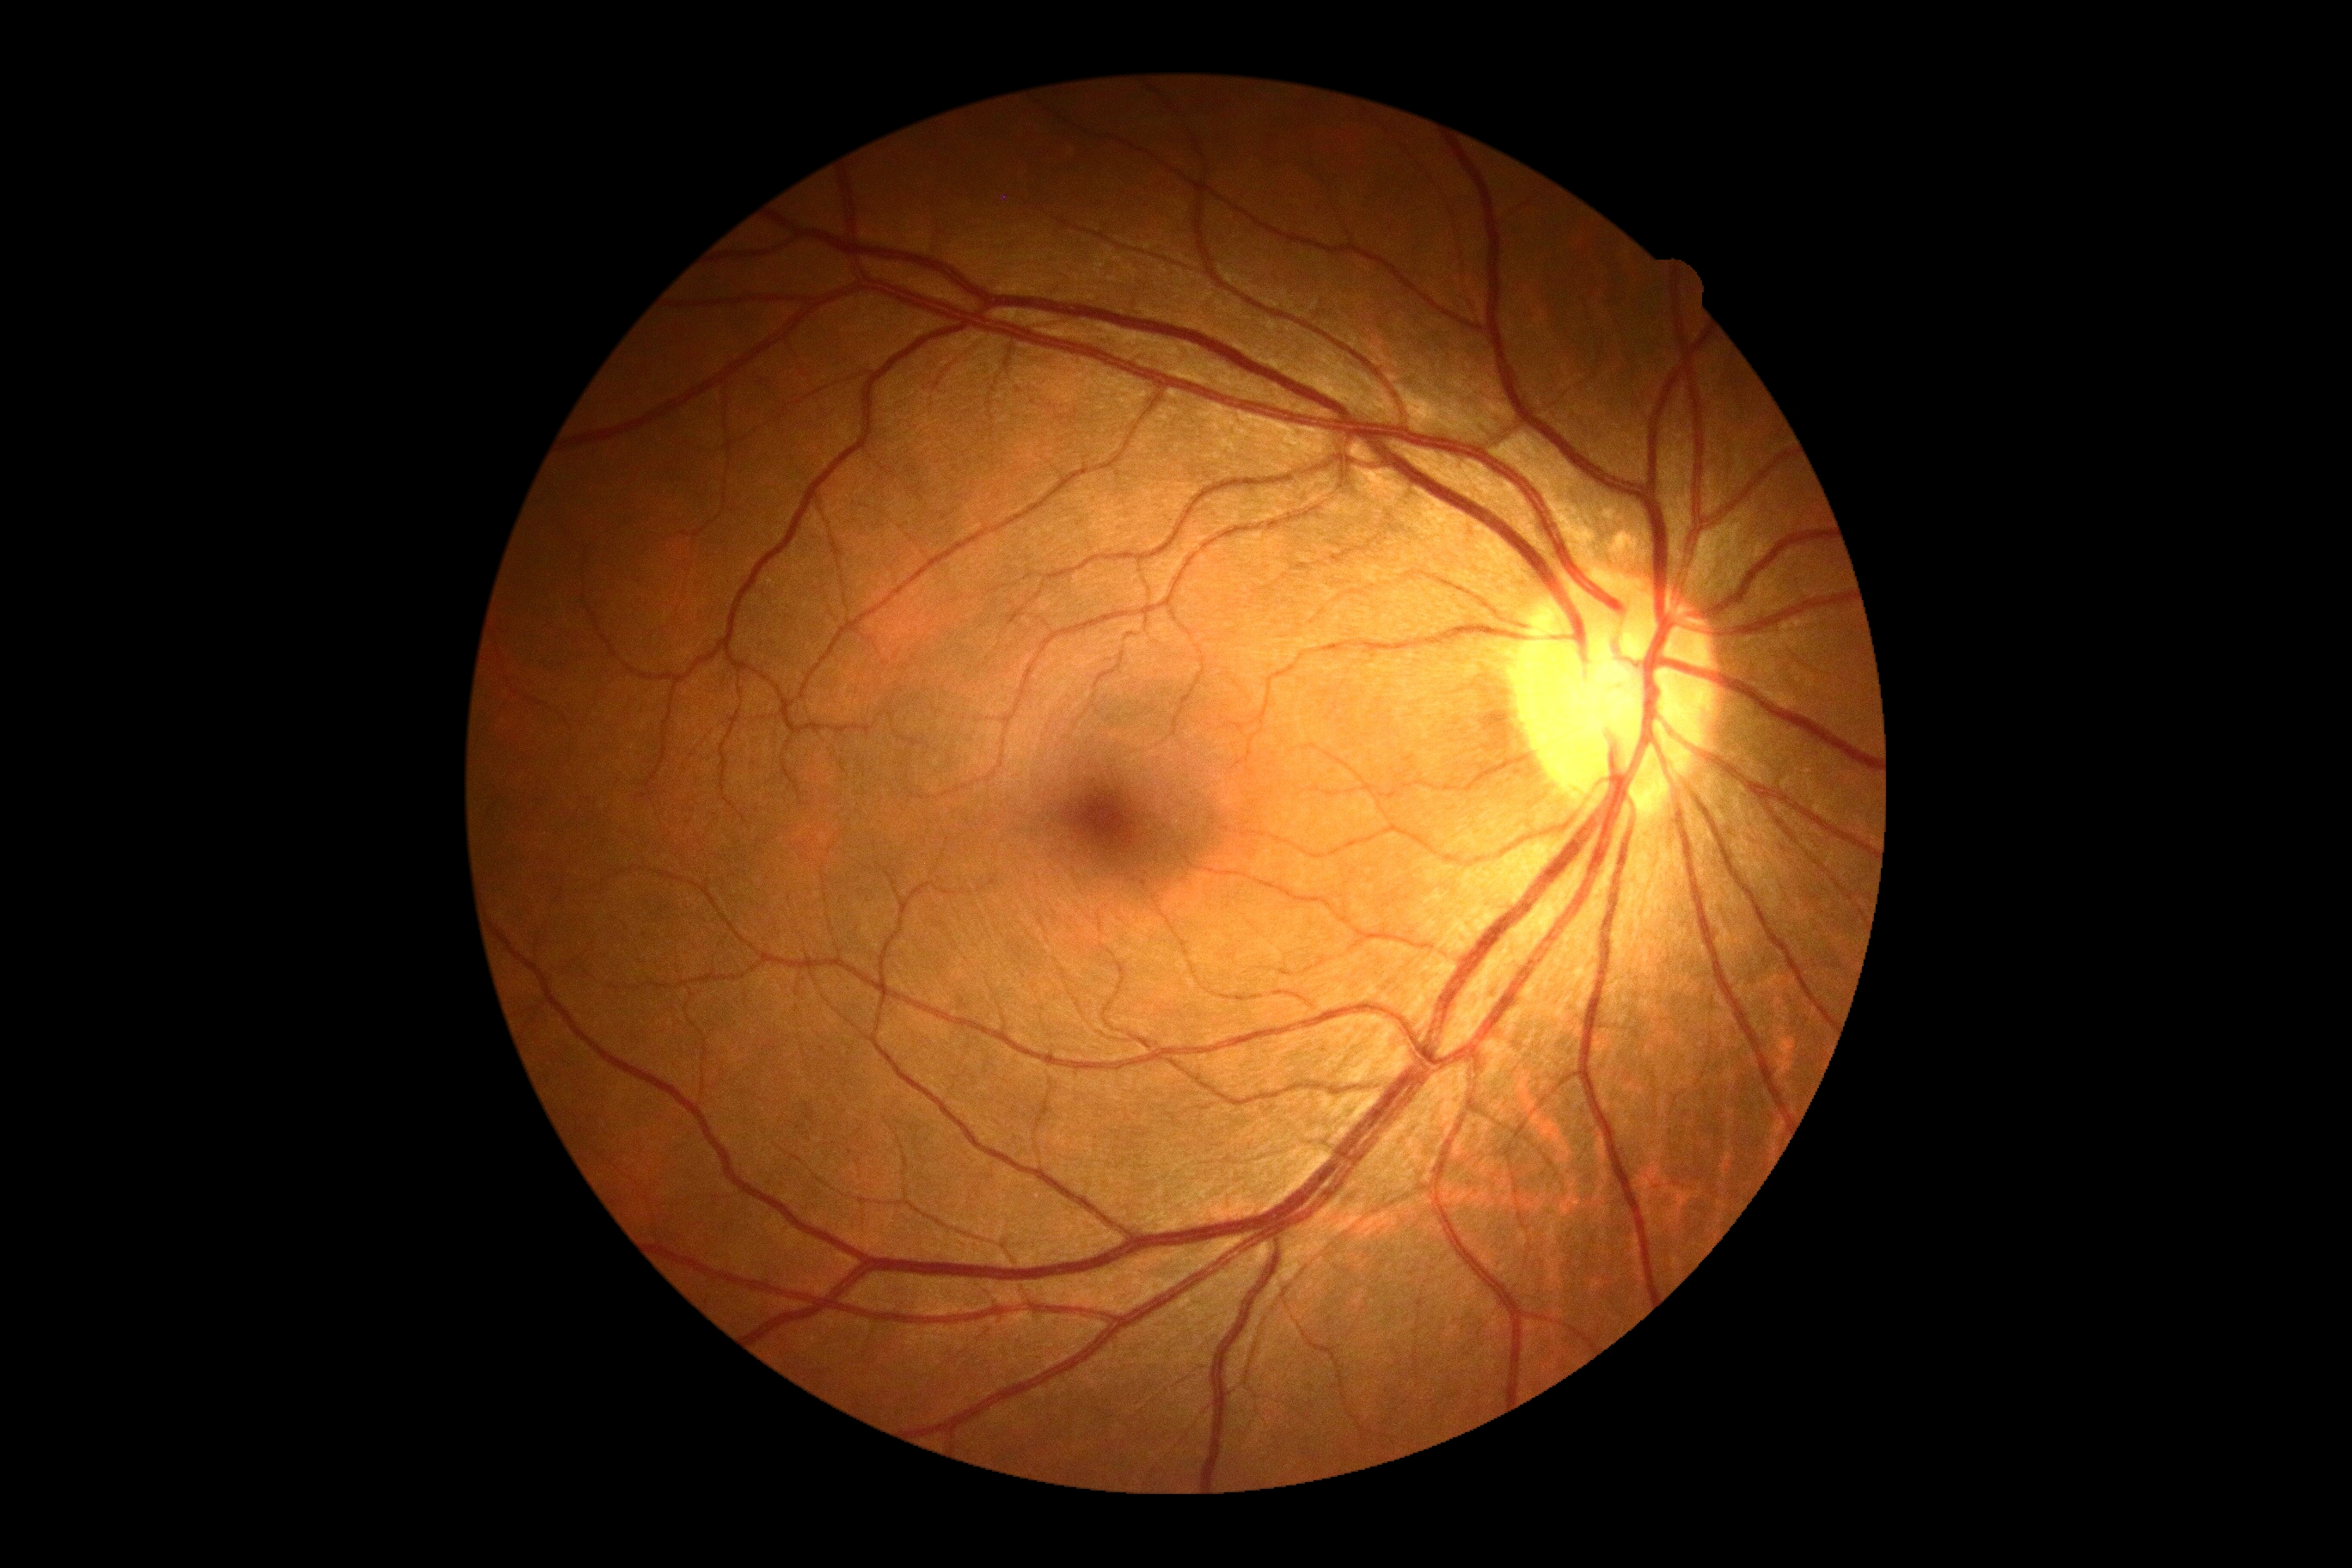 DR grade: 0 (no apparent retinopathy).